Wide-field fundus image from infant ROP screening. Acquired on the Natus RetCam Envision. 1440x1080.
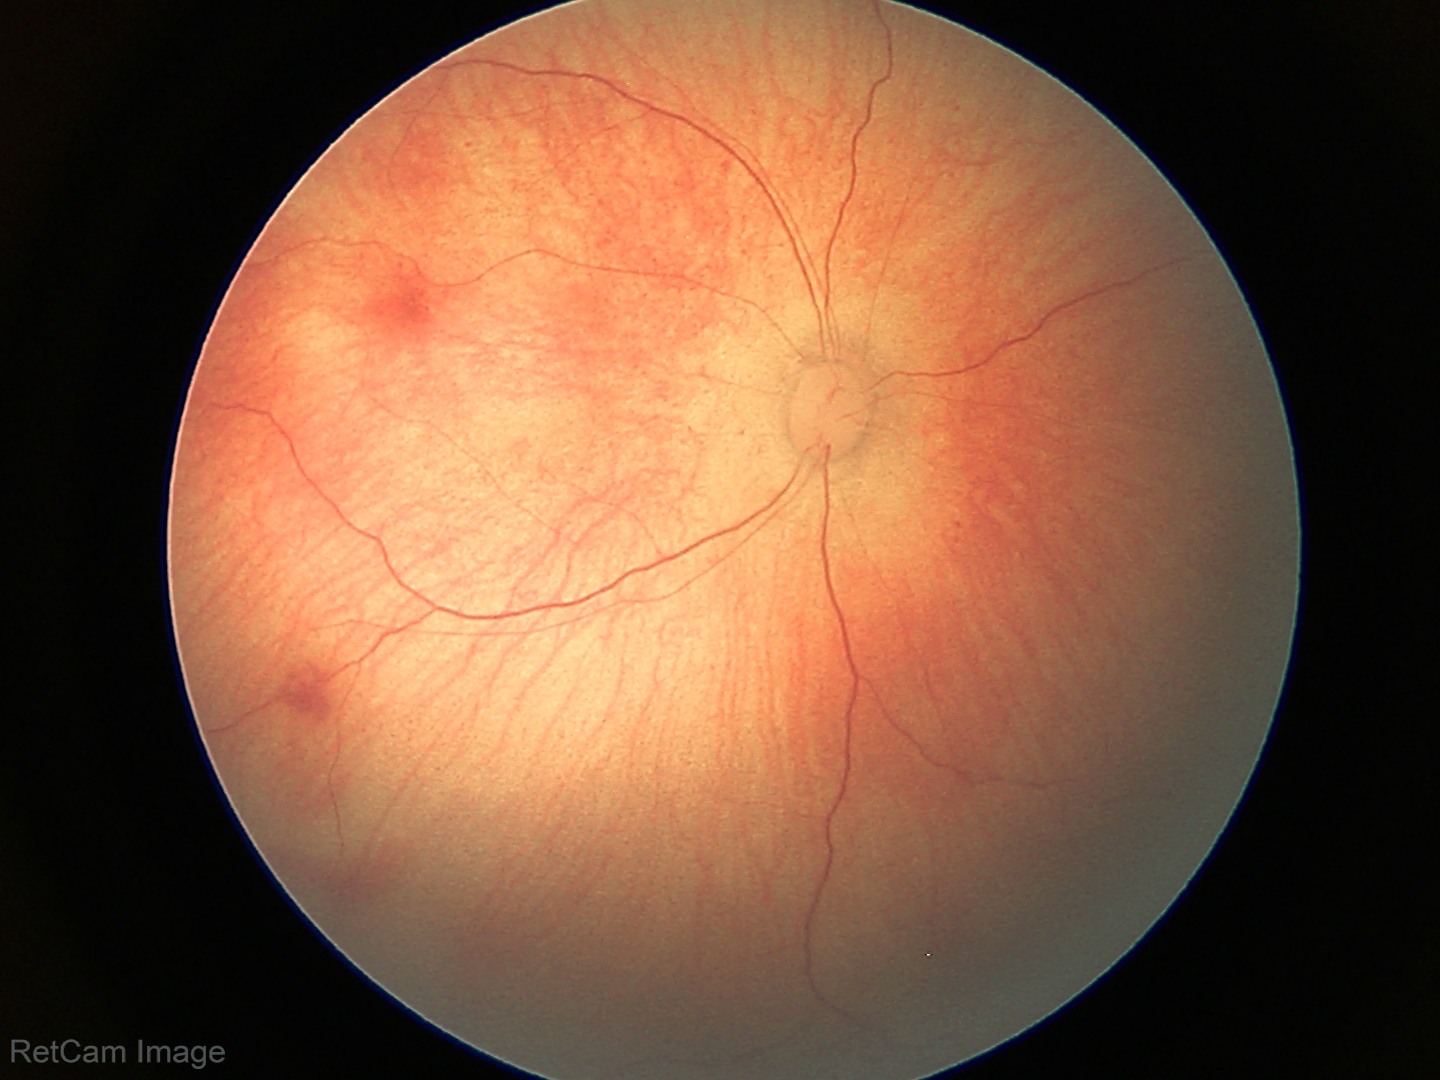

Screening series with retinal hemorrhages.